Image size 610x610; optic disc-centered crop from a color fundus photograph: 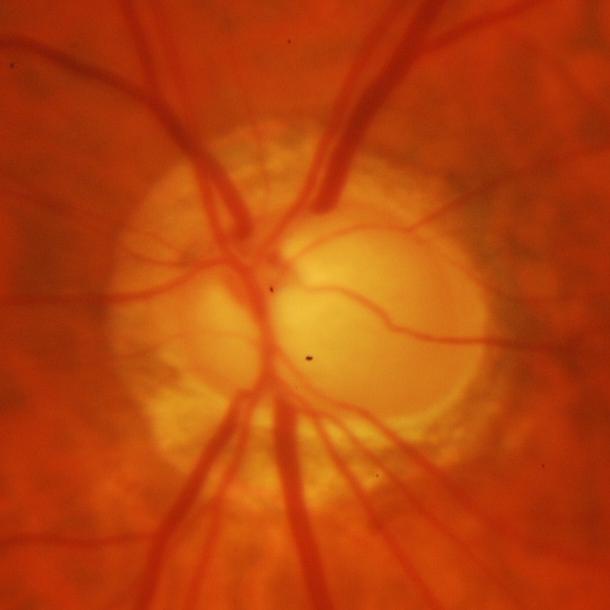 Assessment = evidence of glaucoma.